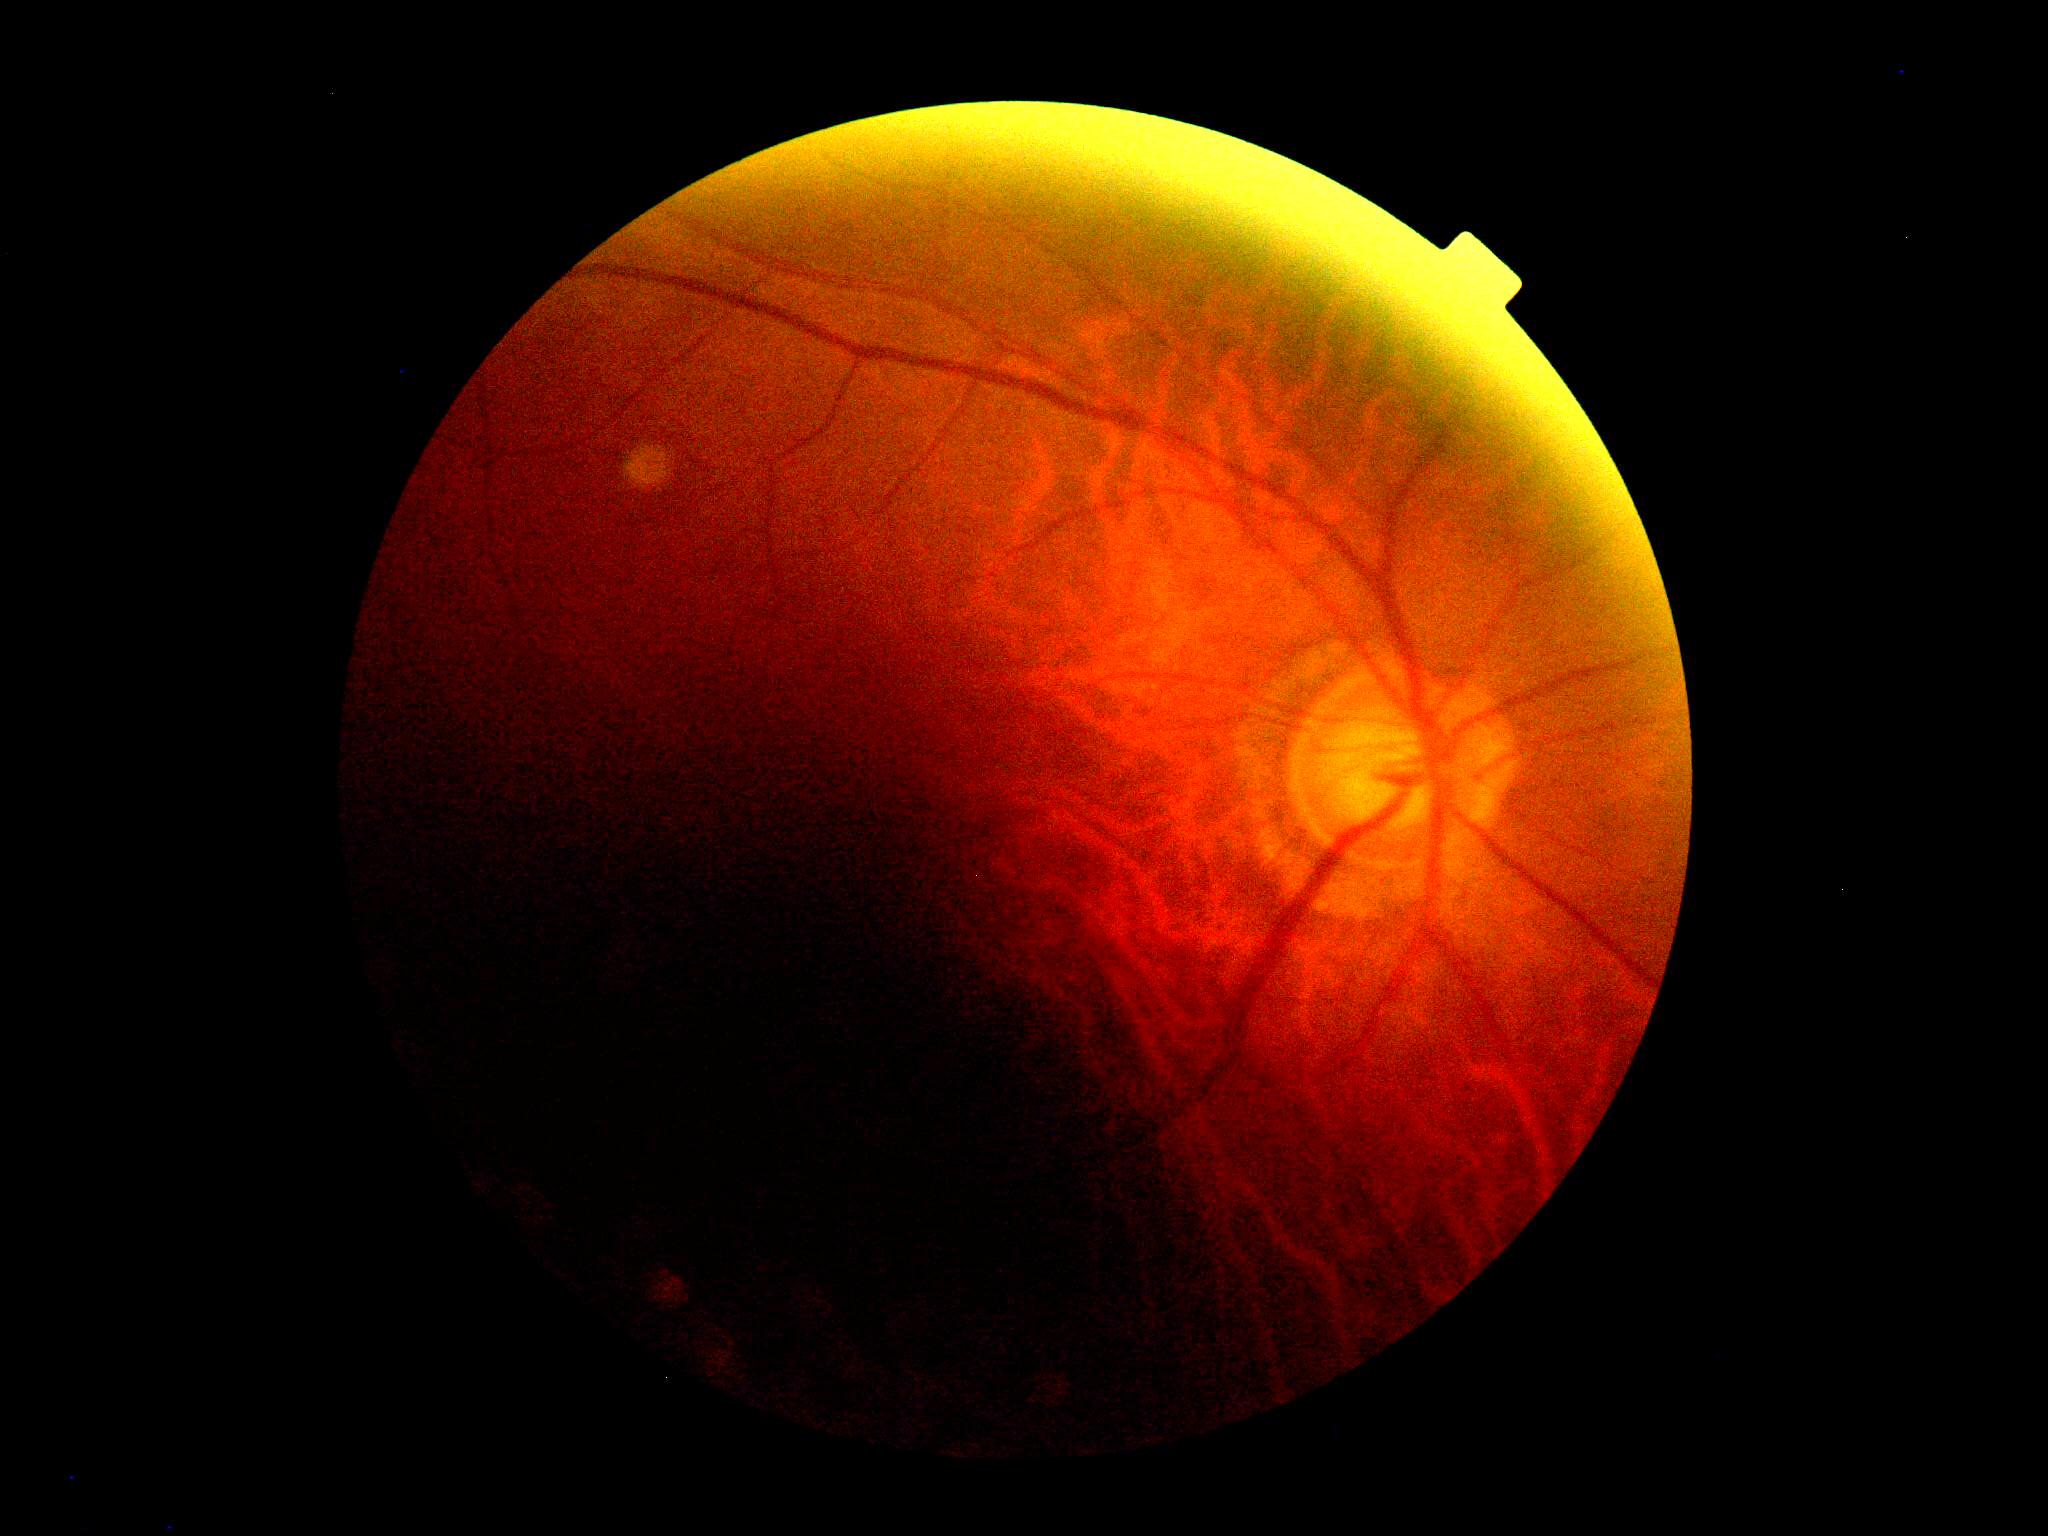
diabetic retinopathy (DR) = ungradable